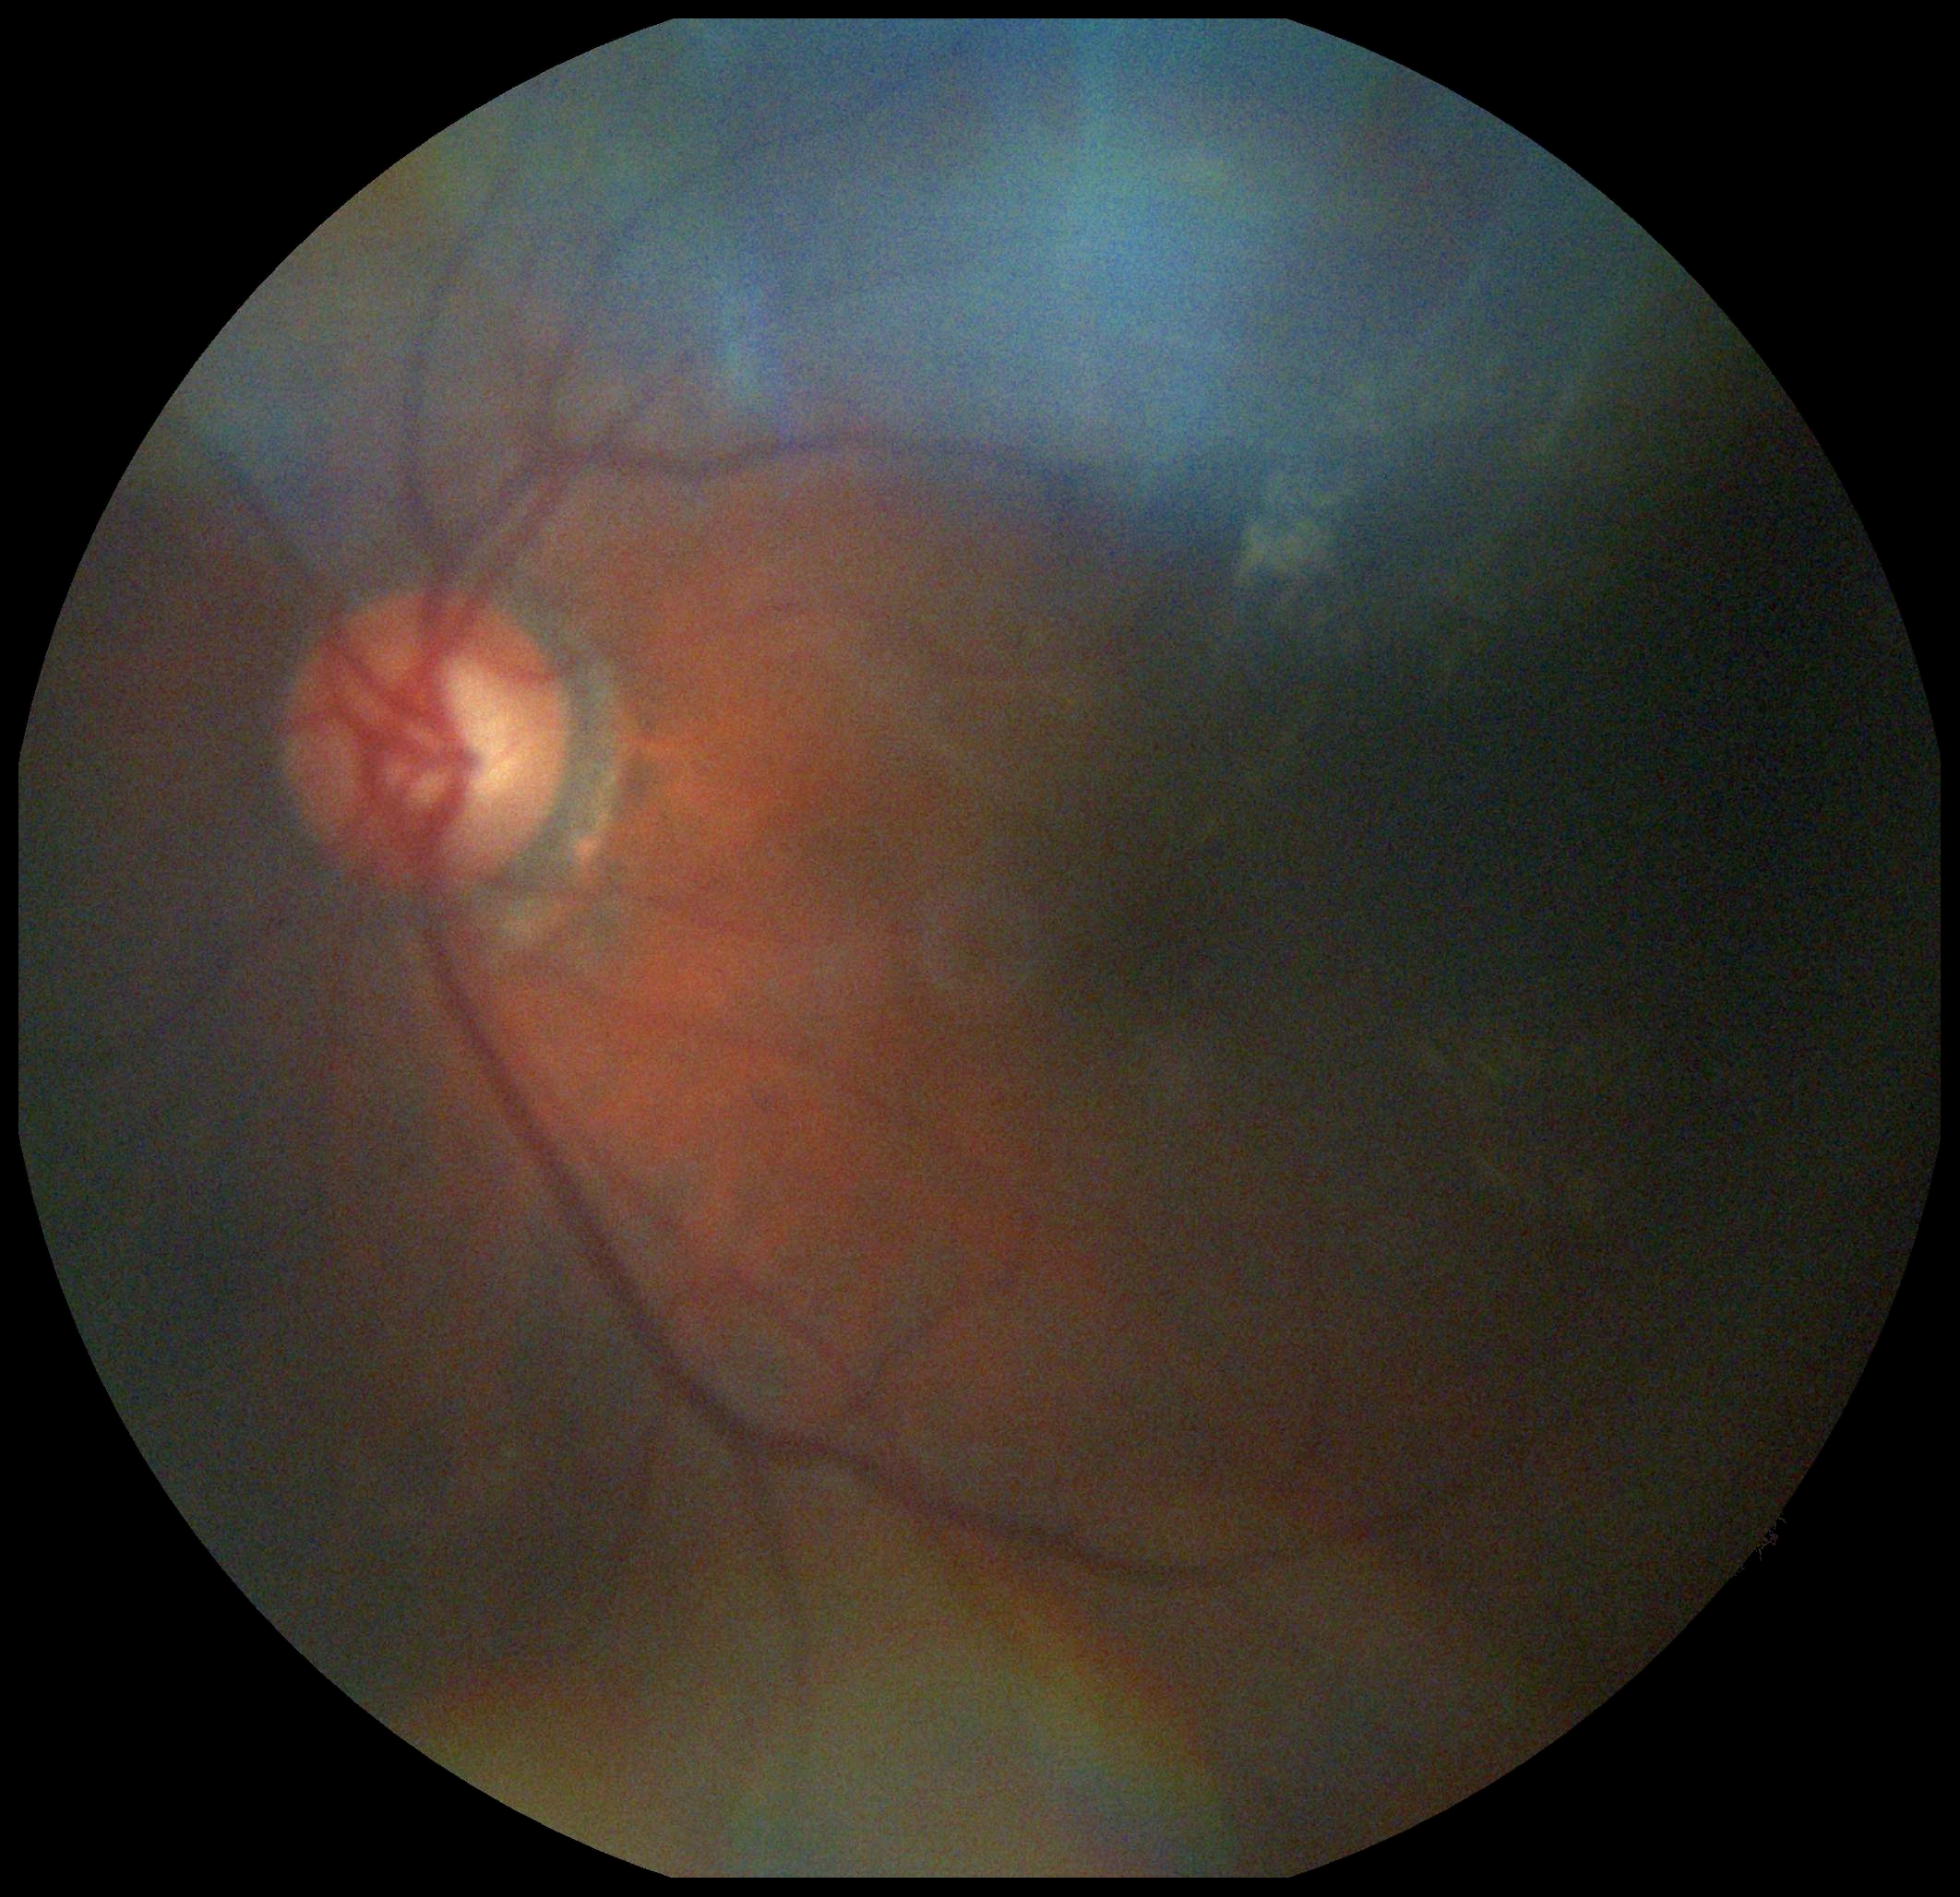

Diabetic retinopathy (DR) is moderate non-proliferative diabetic retinopathy (grade 2).